2352 by 1568 pixels, CFP, FOV: 45 degrees.
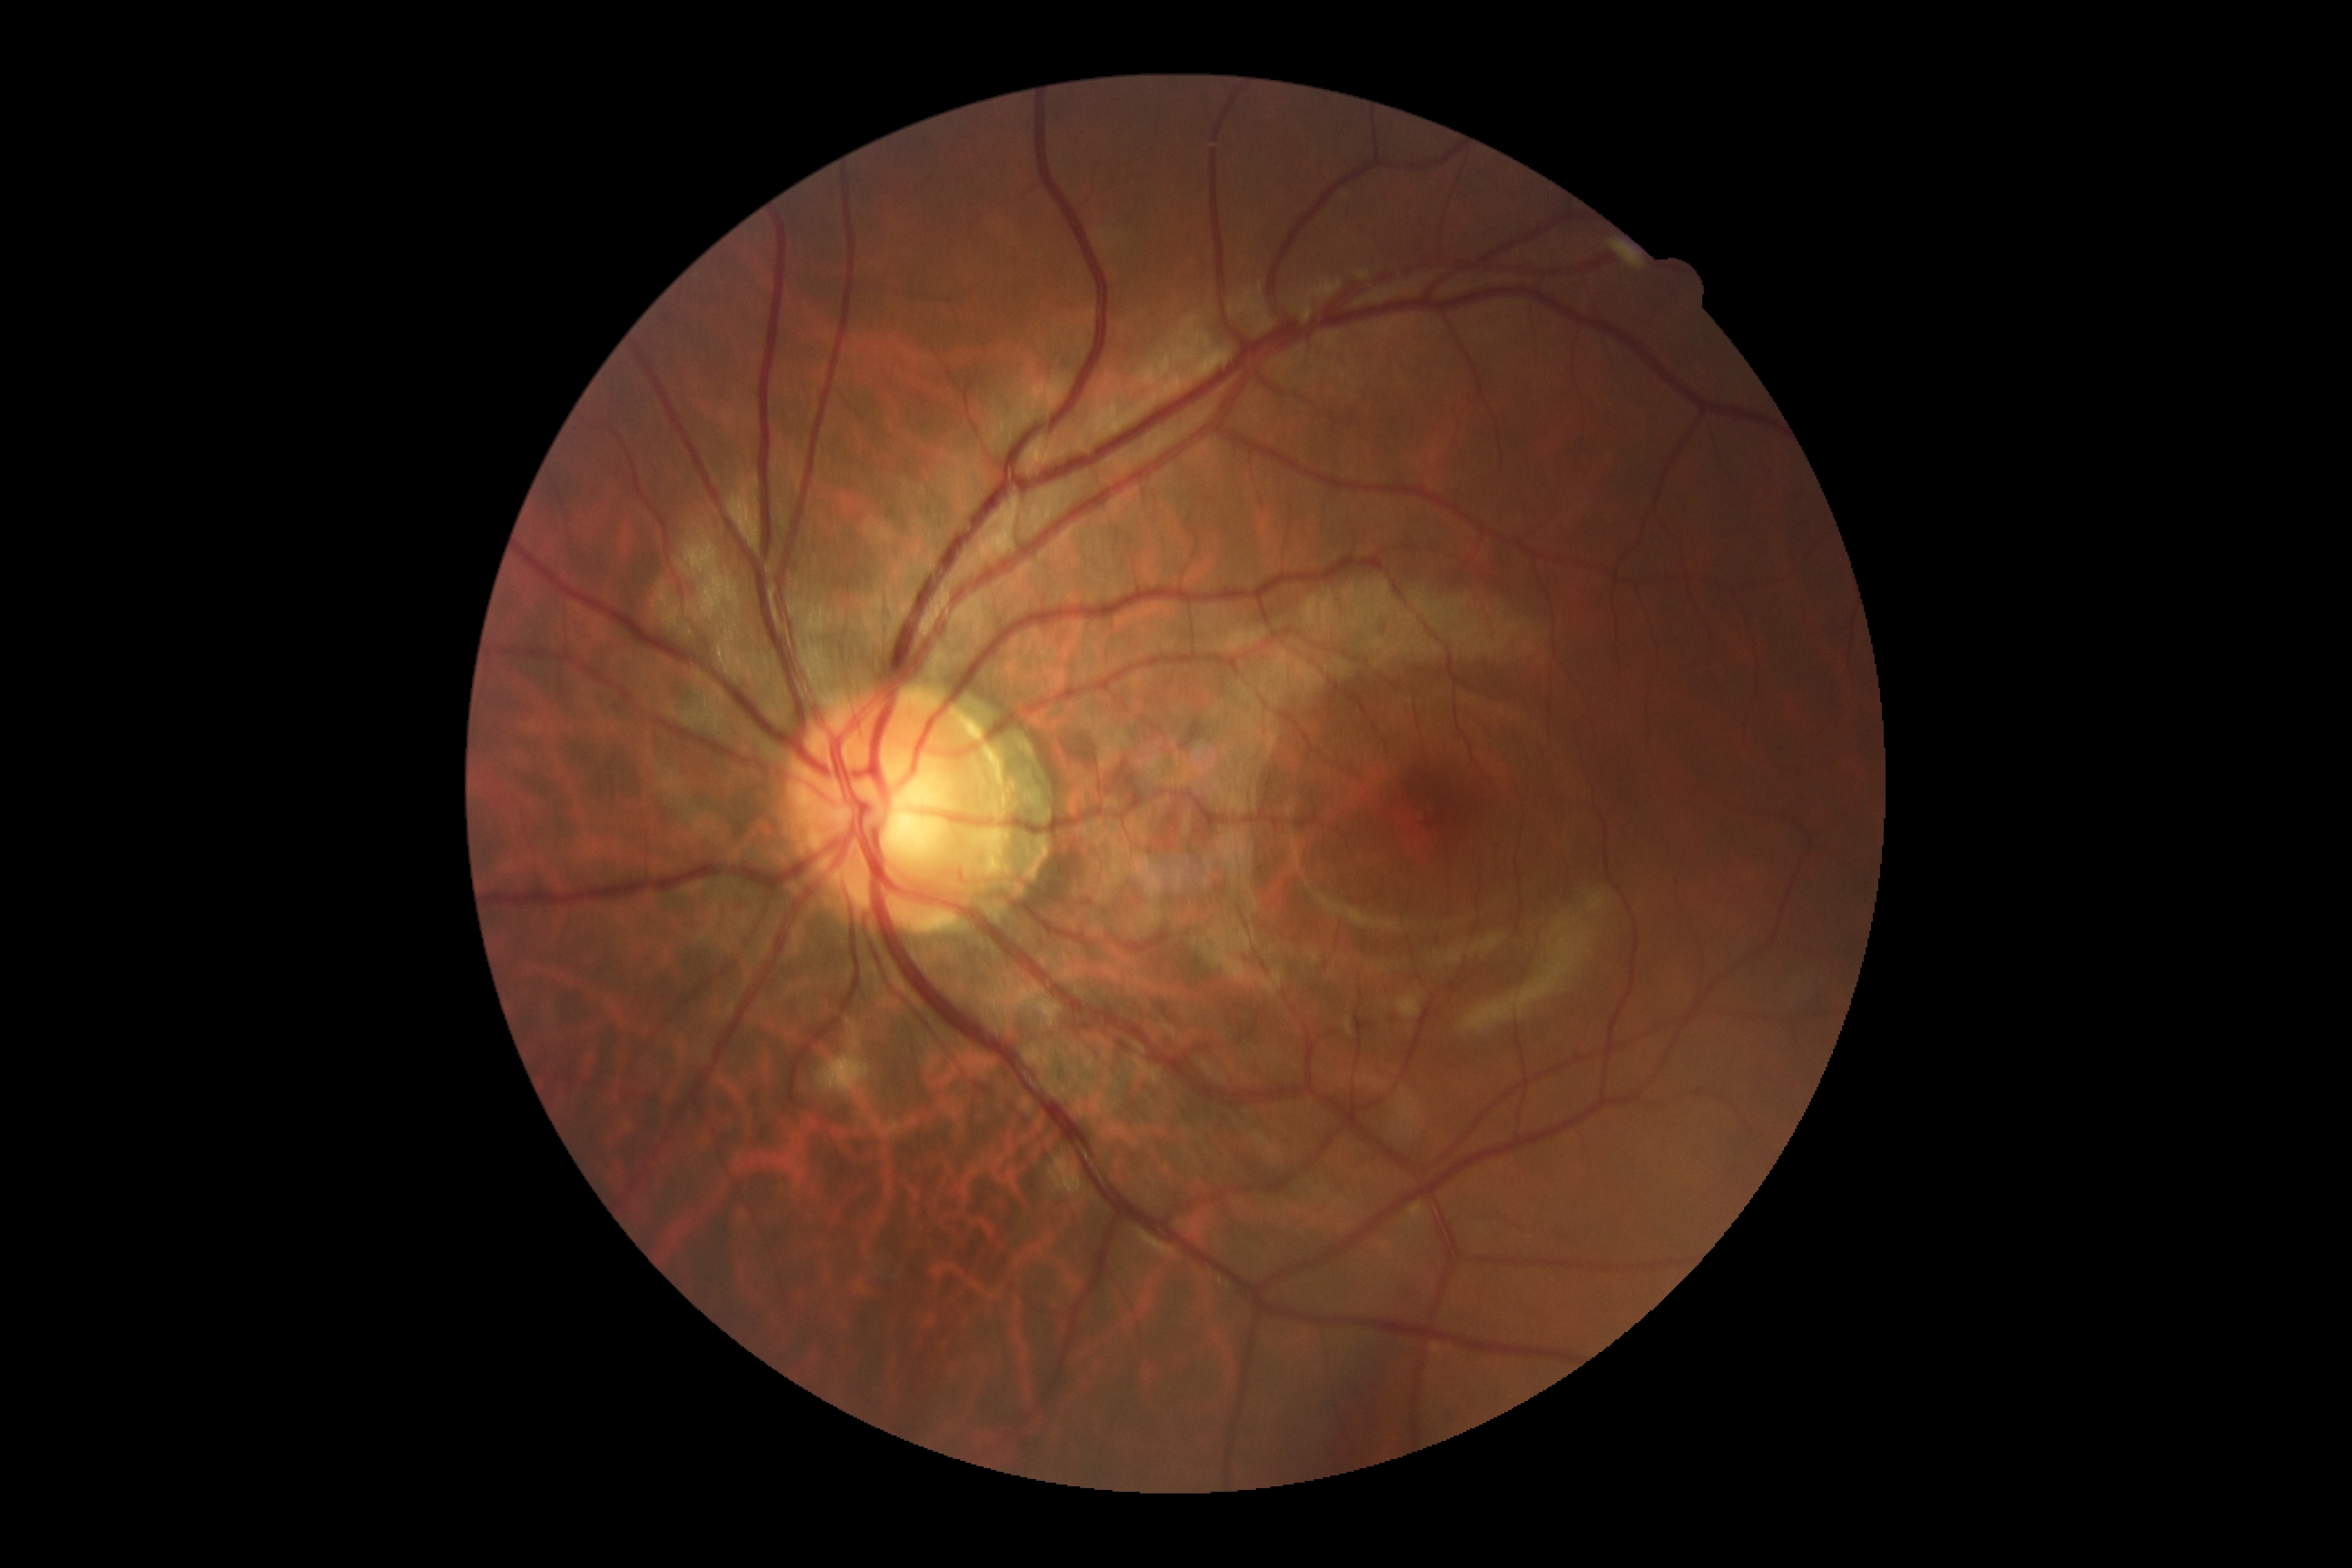 {"dr_grade": "no apparent diabetic retinopathy (grade 0)"}